Captured with the Natus RetCam Envision (130° field of view); infant wide-field retinal image; 1440x1080.
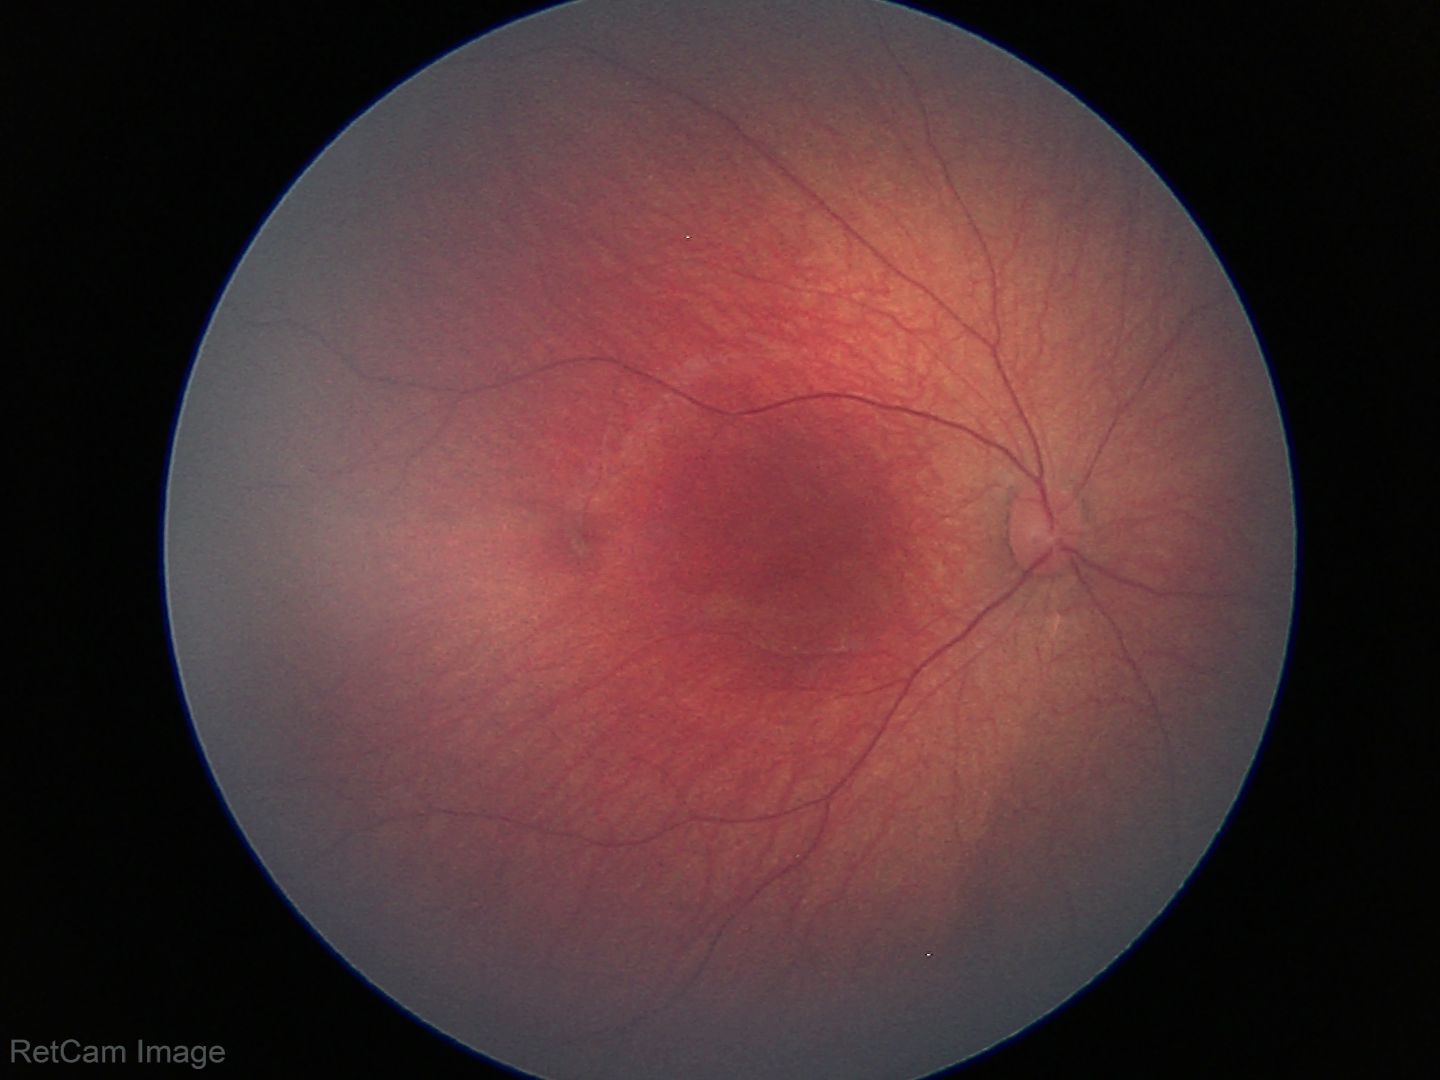

Normal screening examination.